Infant wide-field fundus photograph:
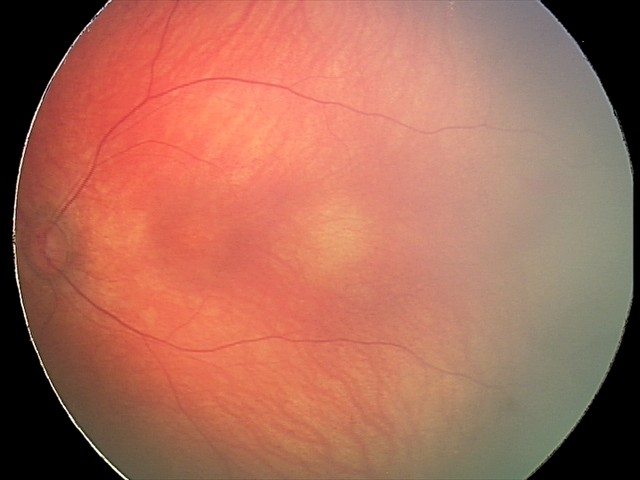 From an examination with diagnosis of retinal hemorrhages.